Phoenix ICON wide-field infant fundus image.
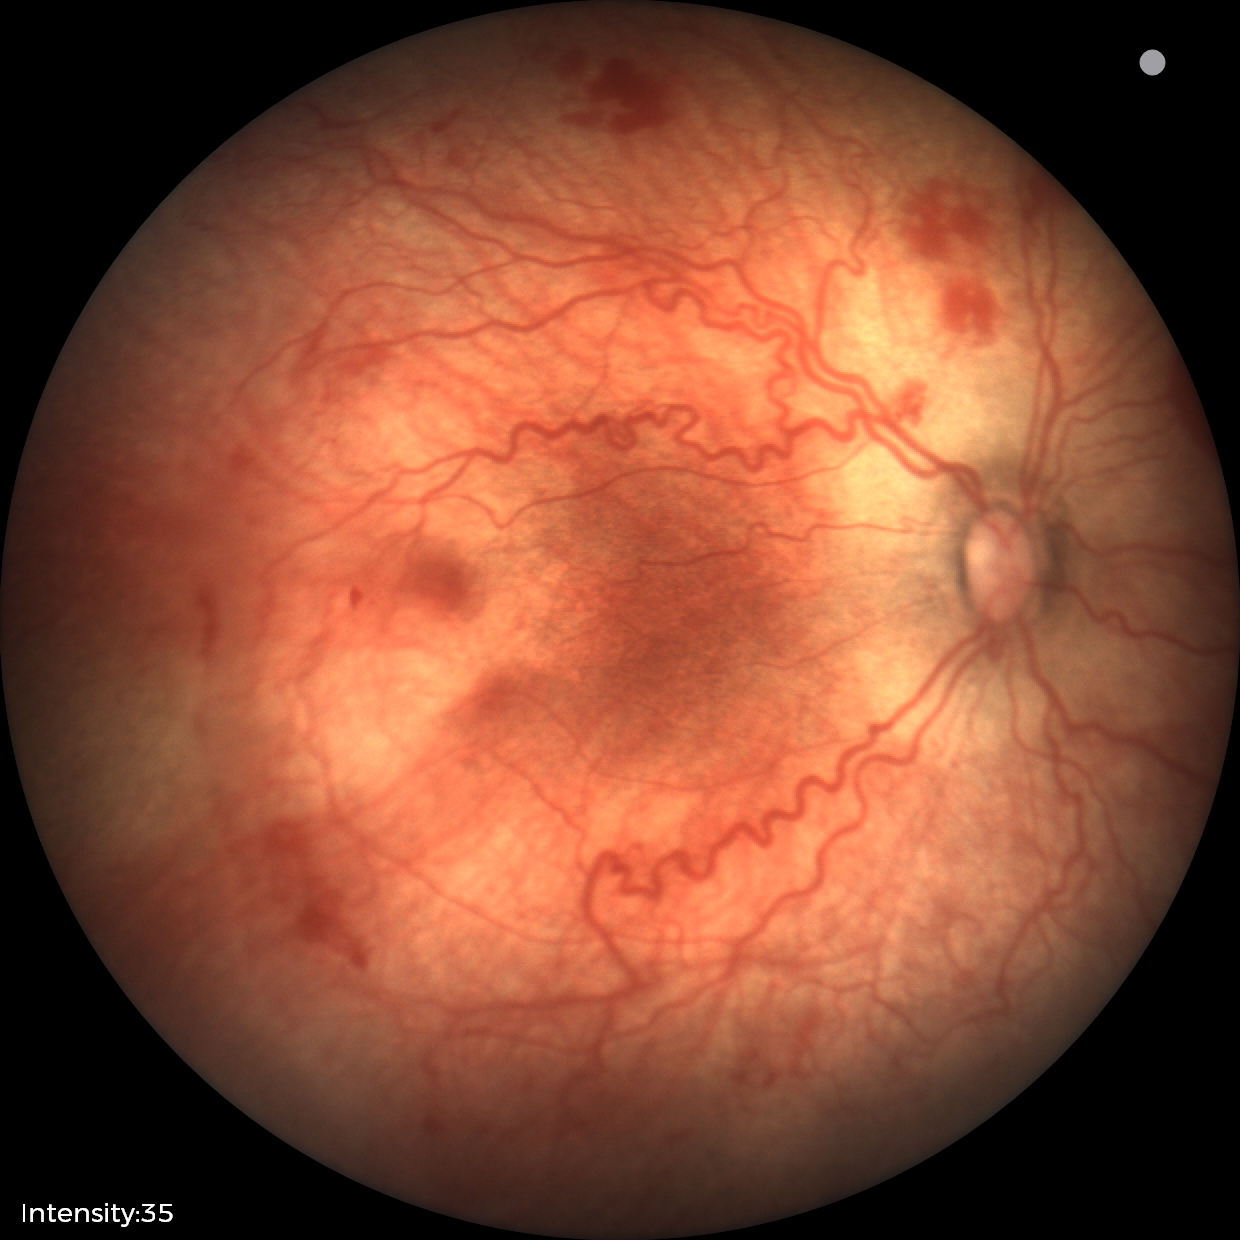
Screening diagnosis: ROP stage 2; plus disease — abnormal dilation and tortuosity of the posterior pole retinal vessels.